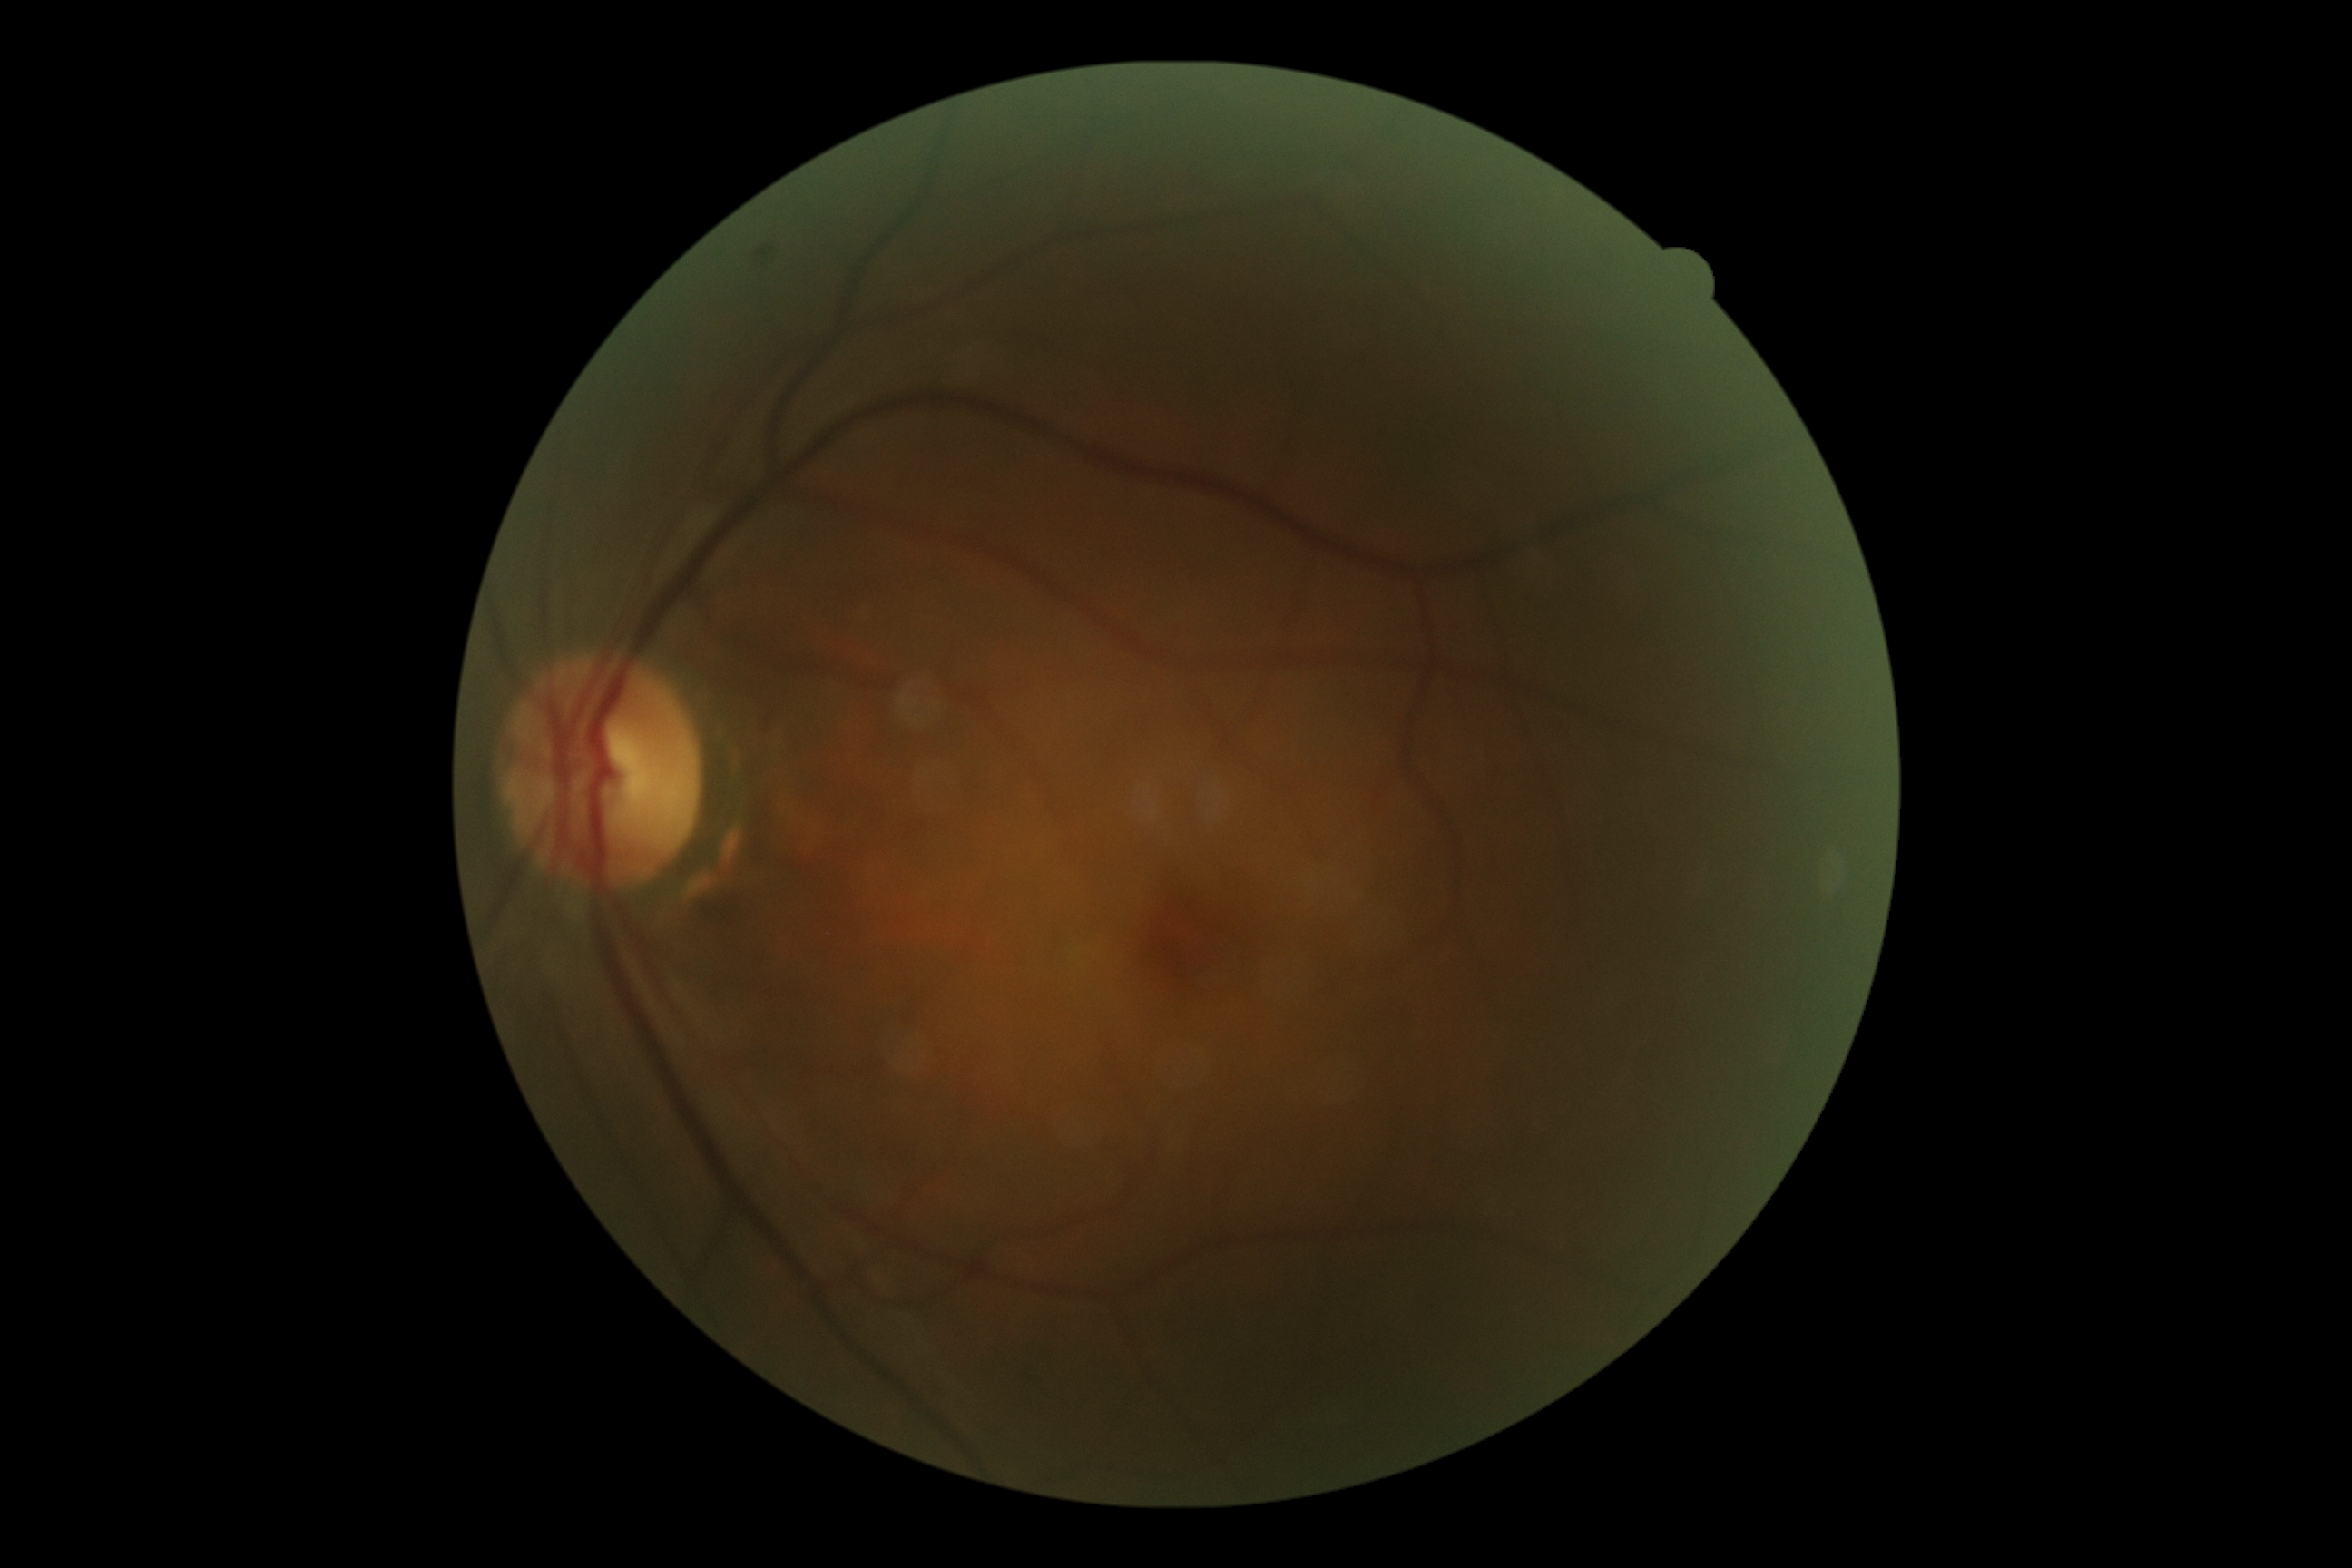
No diabetic retinal disease findings. DR stage is 0.